2102x1736px
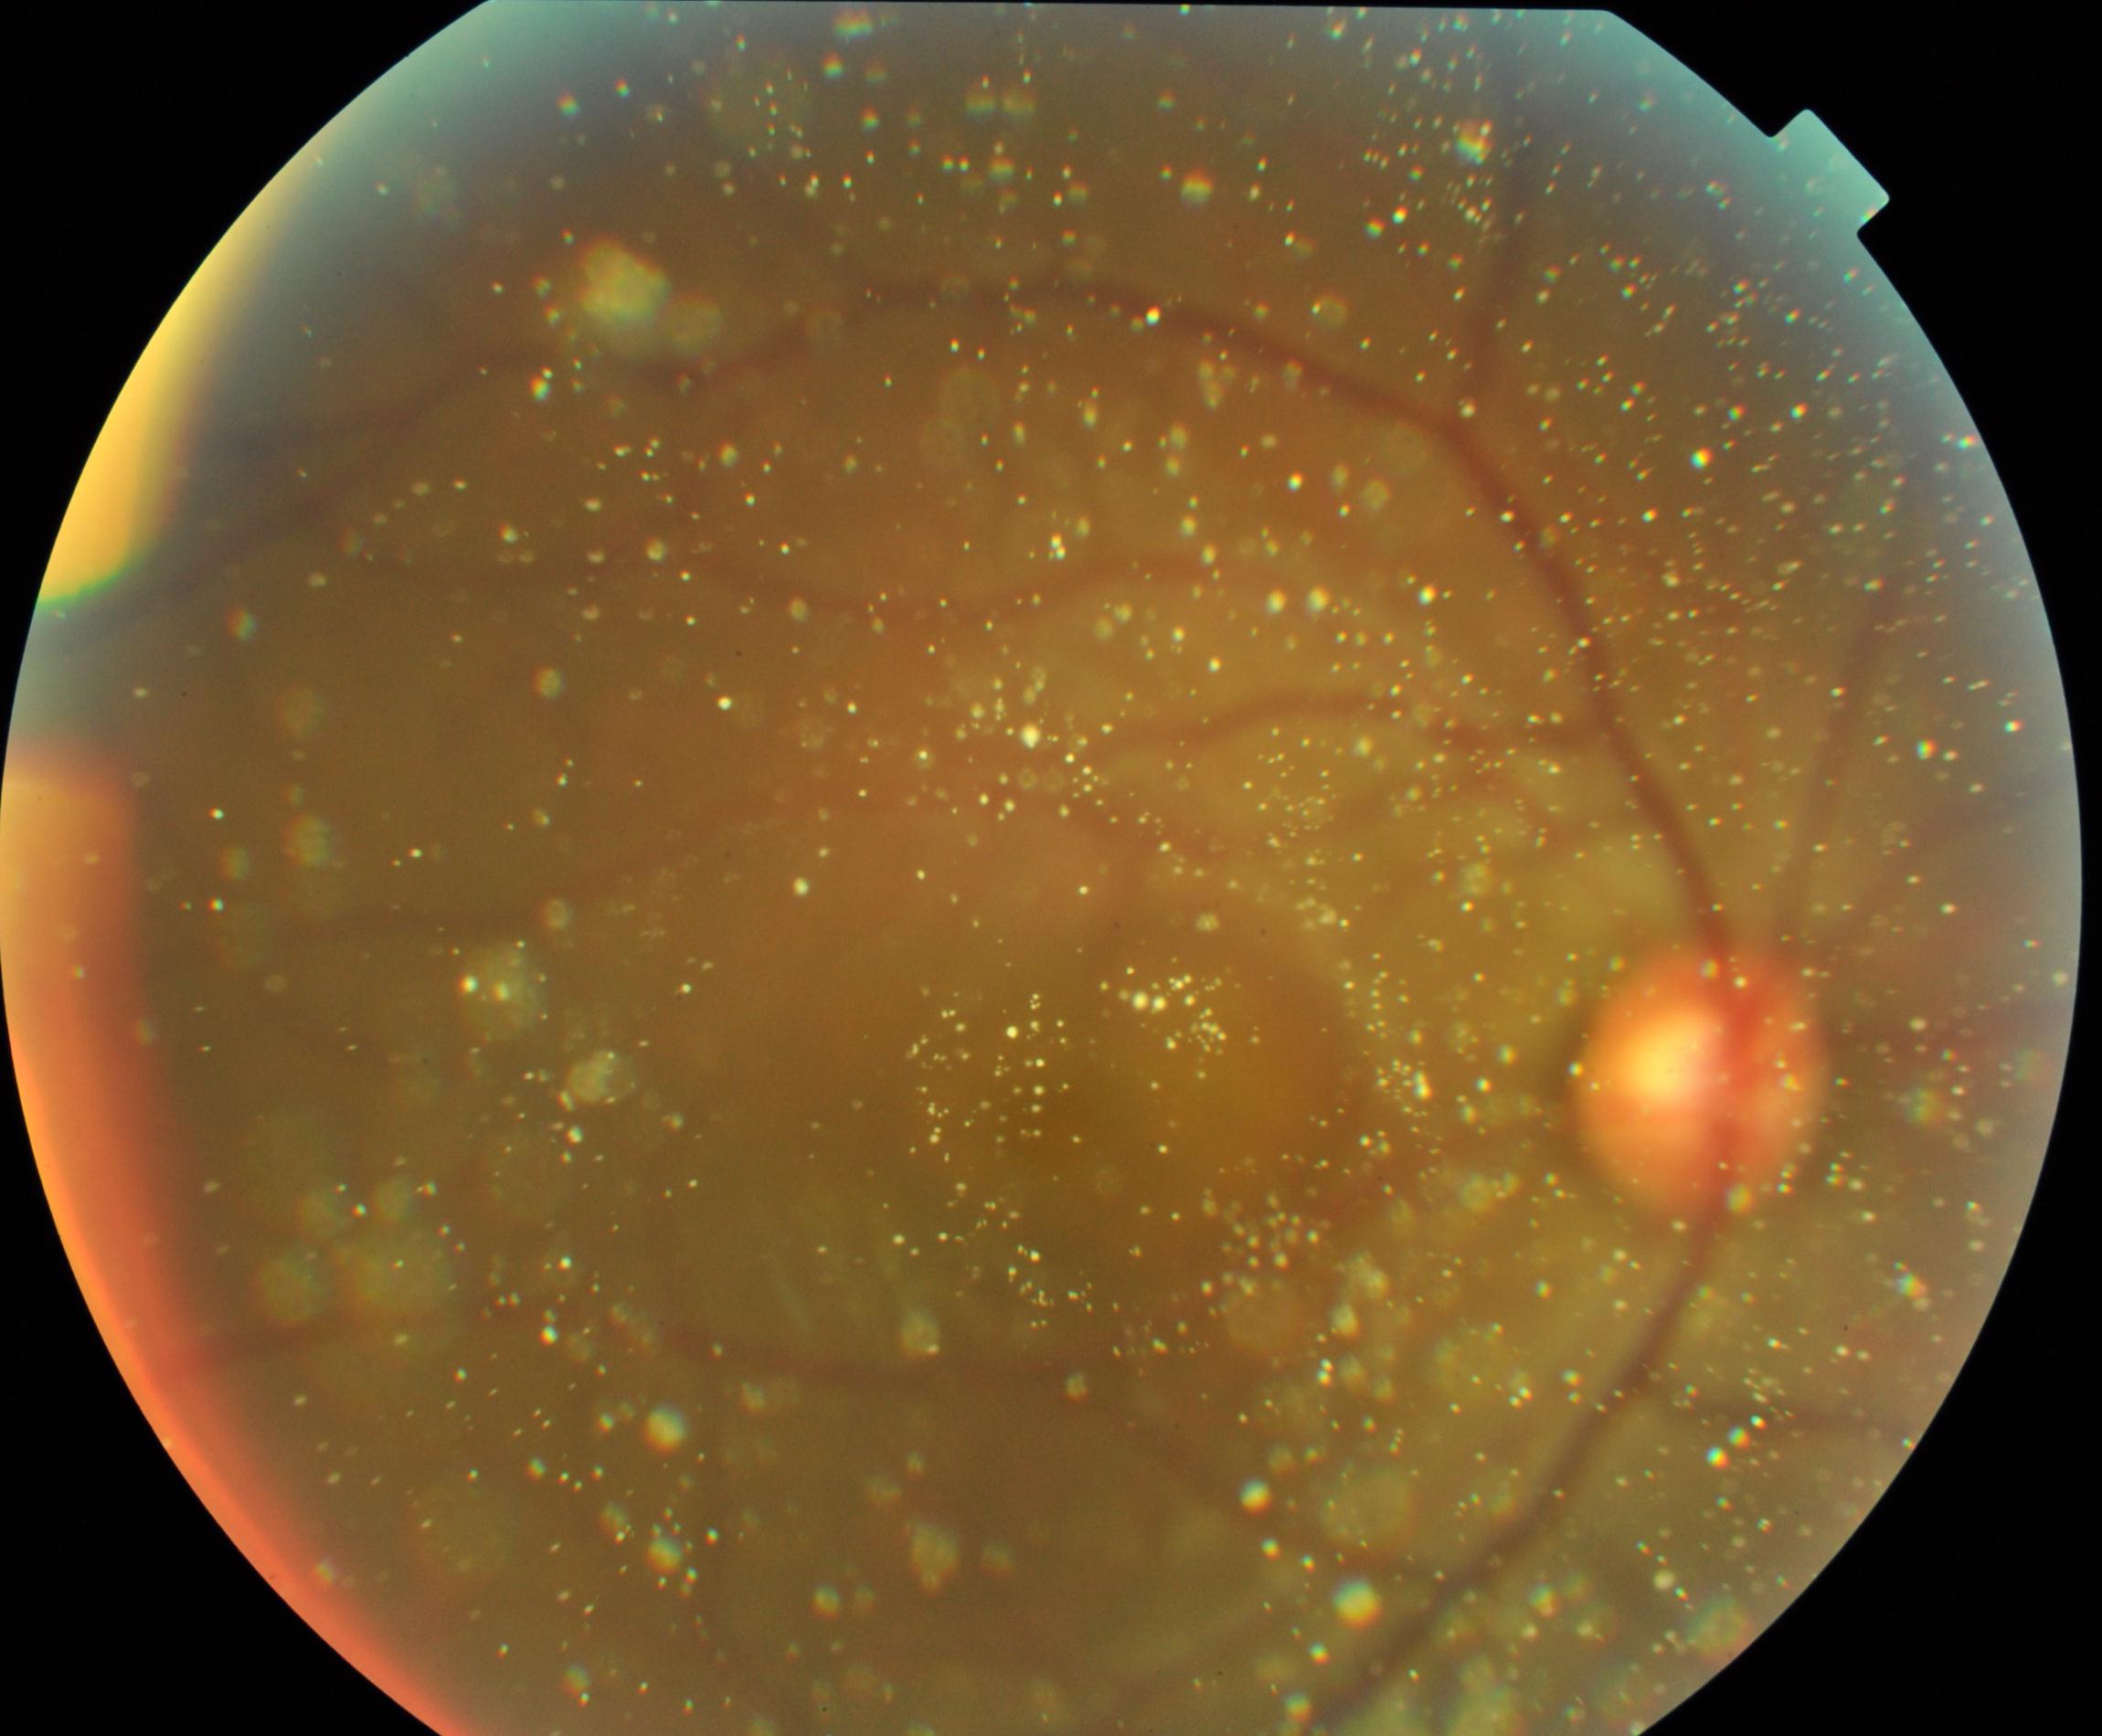

Consistent with vitreous particles. Features include vitreous opacities including asteroid hyalosis, synchysis scintillans, and deposits of familial amyloidosis.